2352 x 1568 pixels
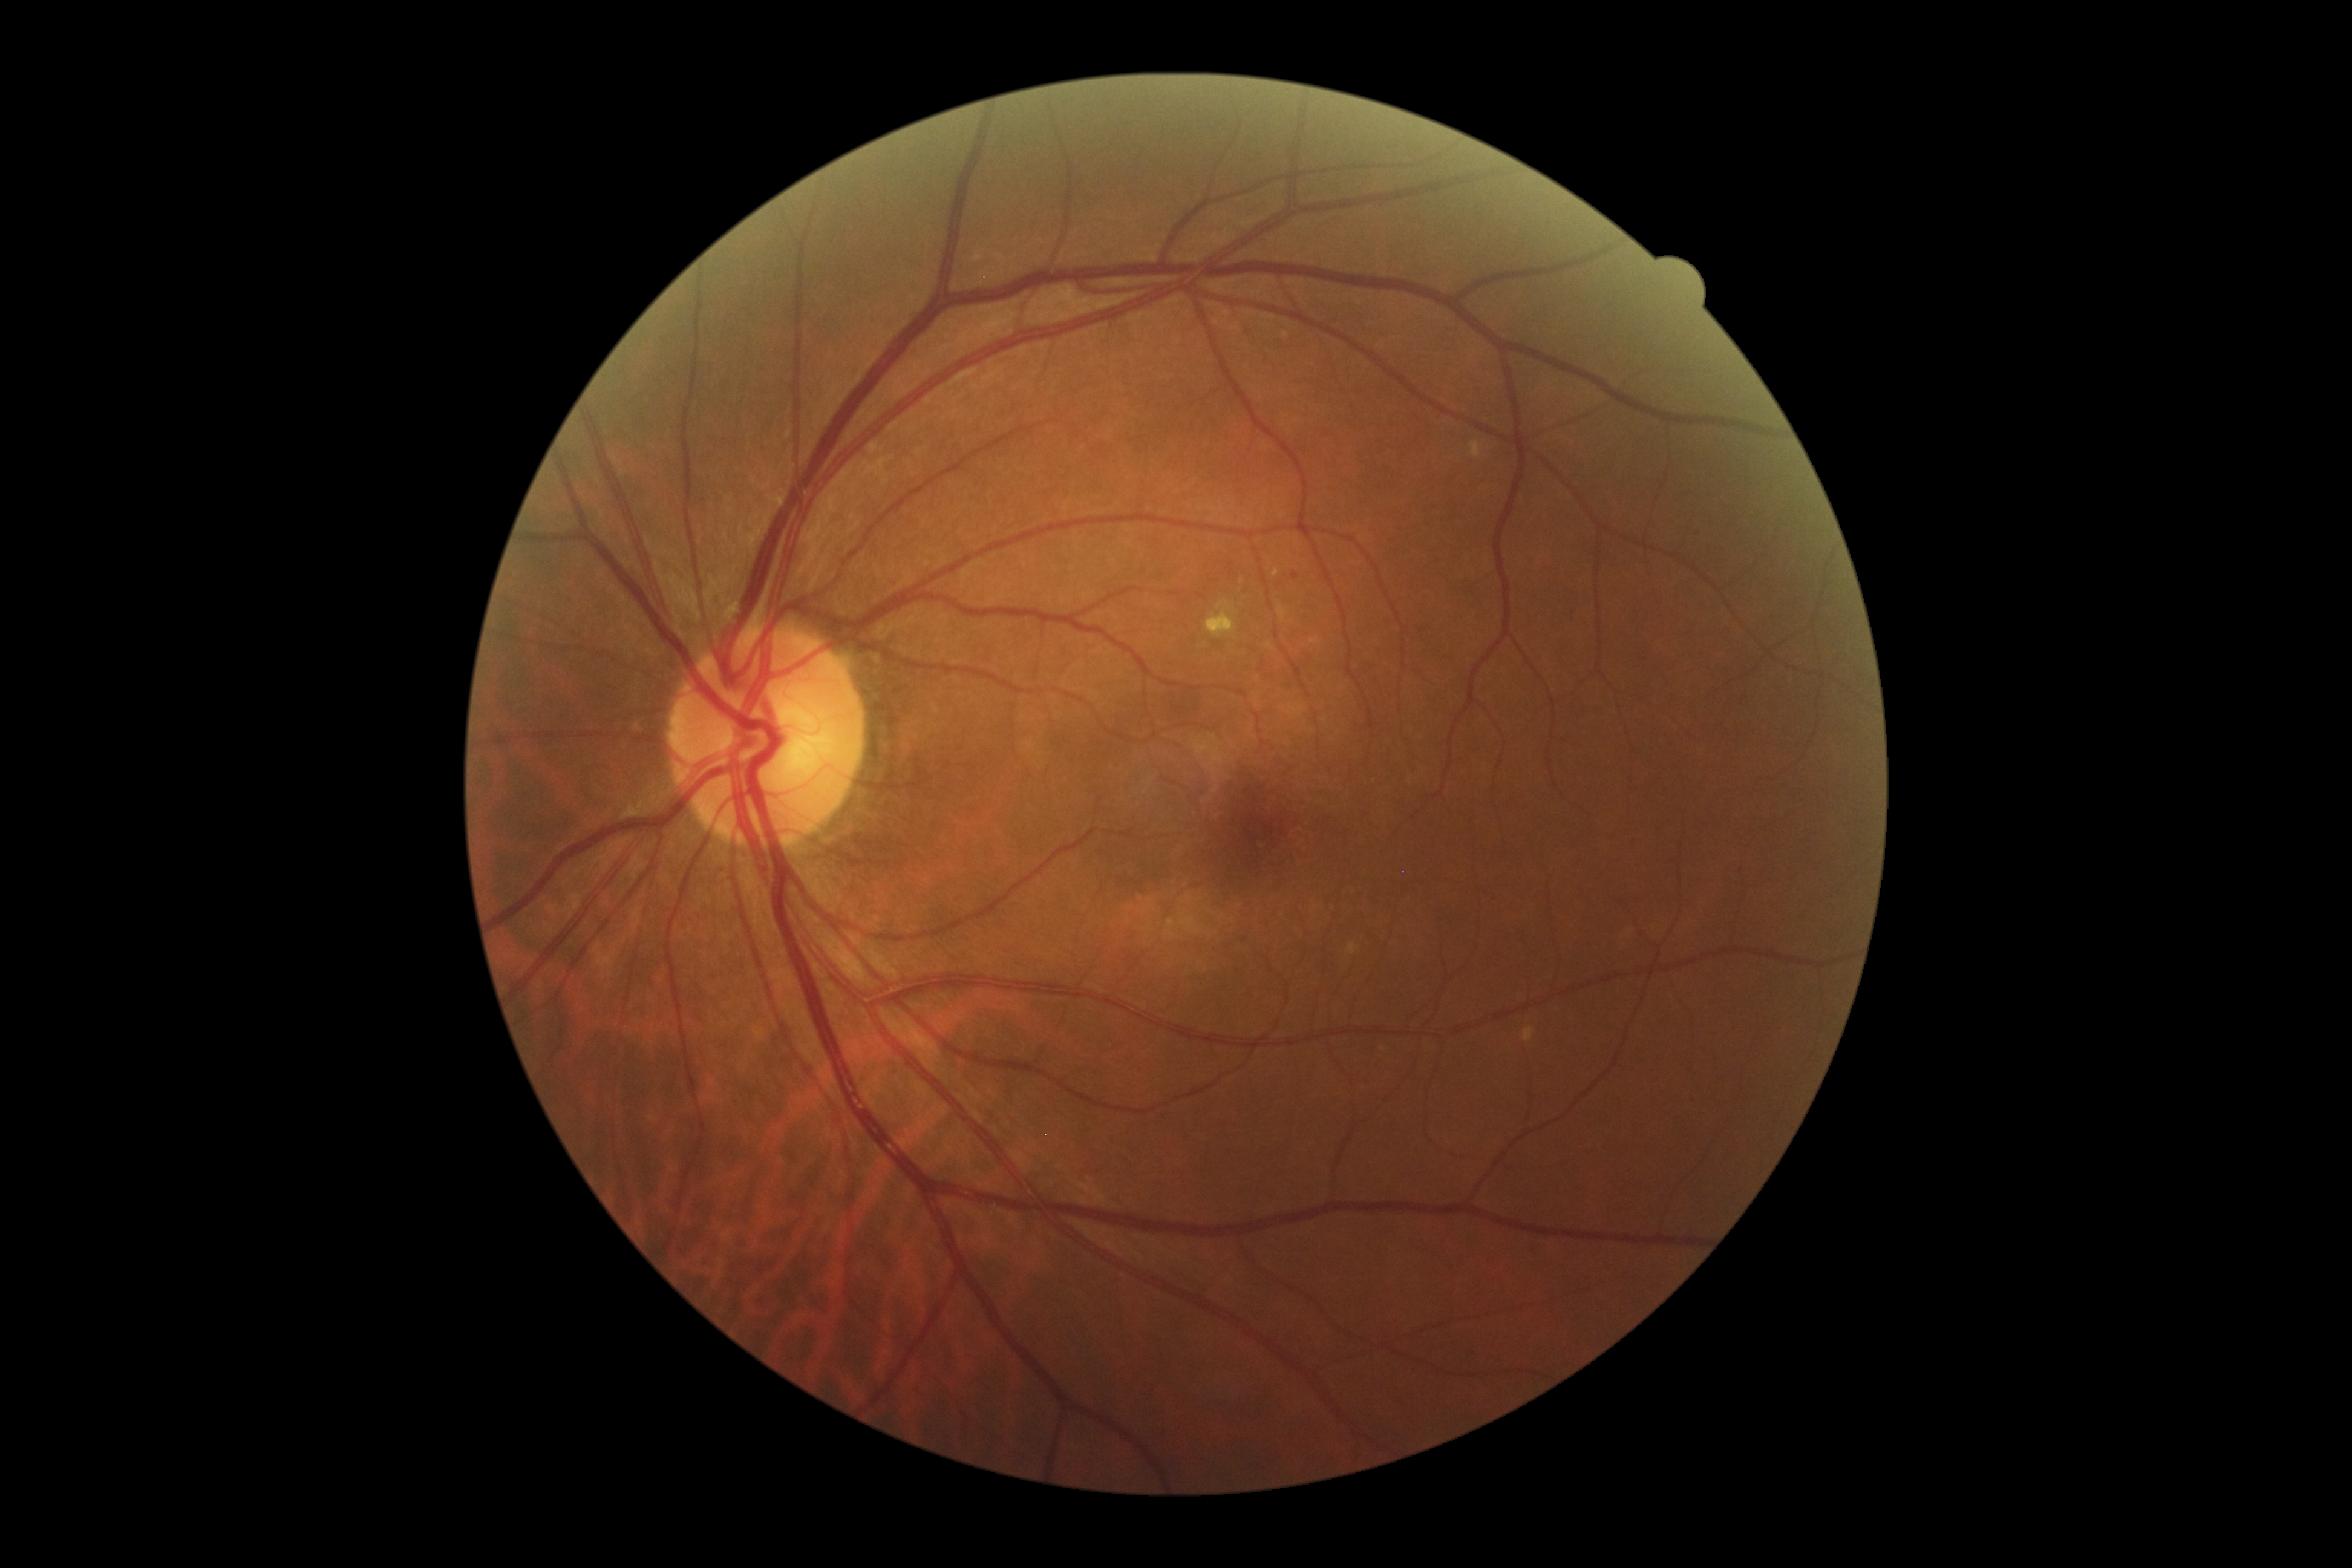 diabetic retinopathy grade: 2 (moderate NPDR)